Acquired with a Remidio FOP fundus camera
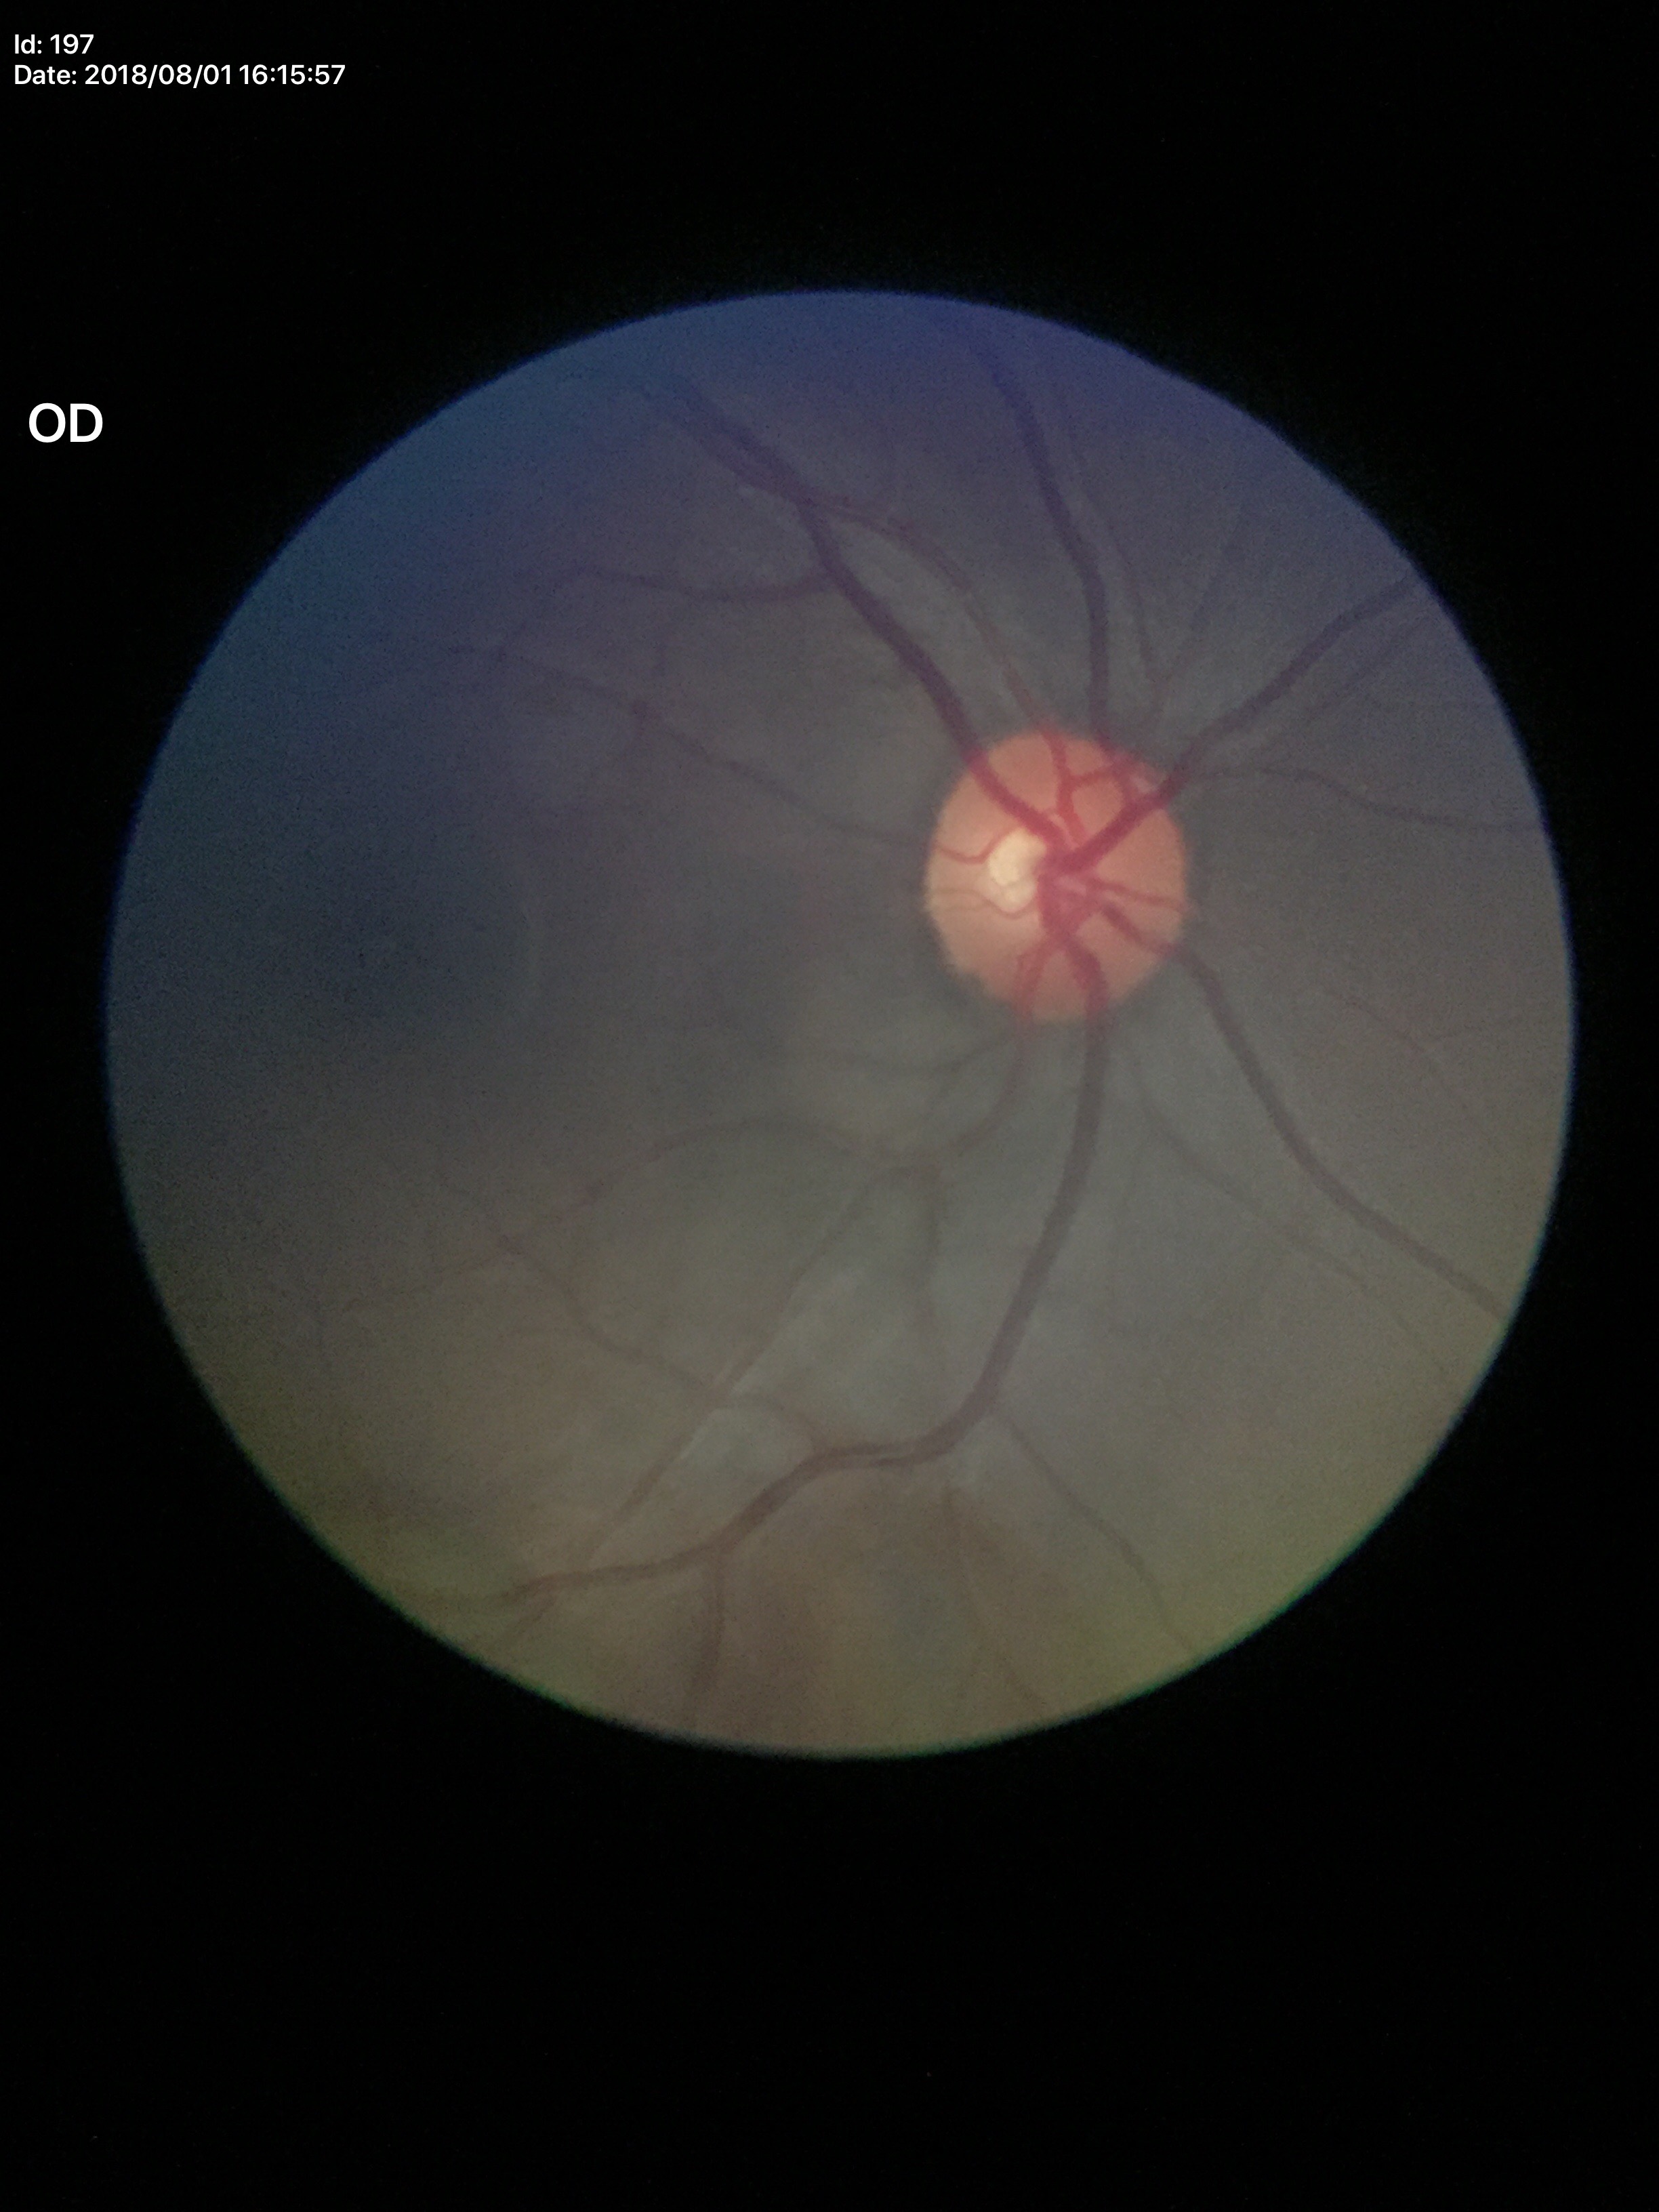 vertical CDR (VCDR)=0.52
horizontal C/D ratio (HCDR)=0.49
Glaucoma assessment=no suspicious findings (unanimous normal call)
area cup-to-disc ratio (ACDR)=0.26